240 x 240 pixels:
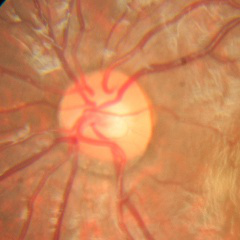

Glaucoma diagnosis: no signs of glaucoma.